Image size 1932x1932:
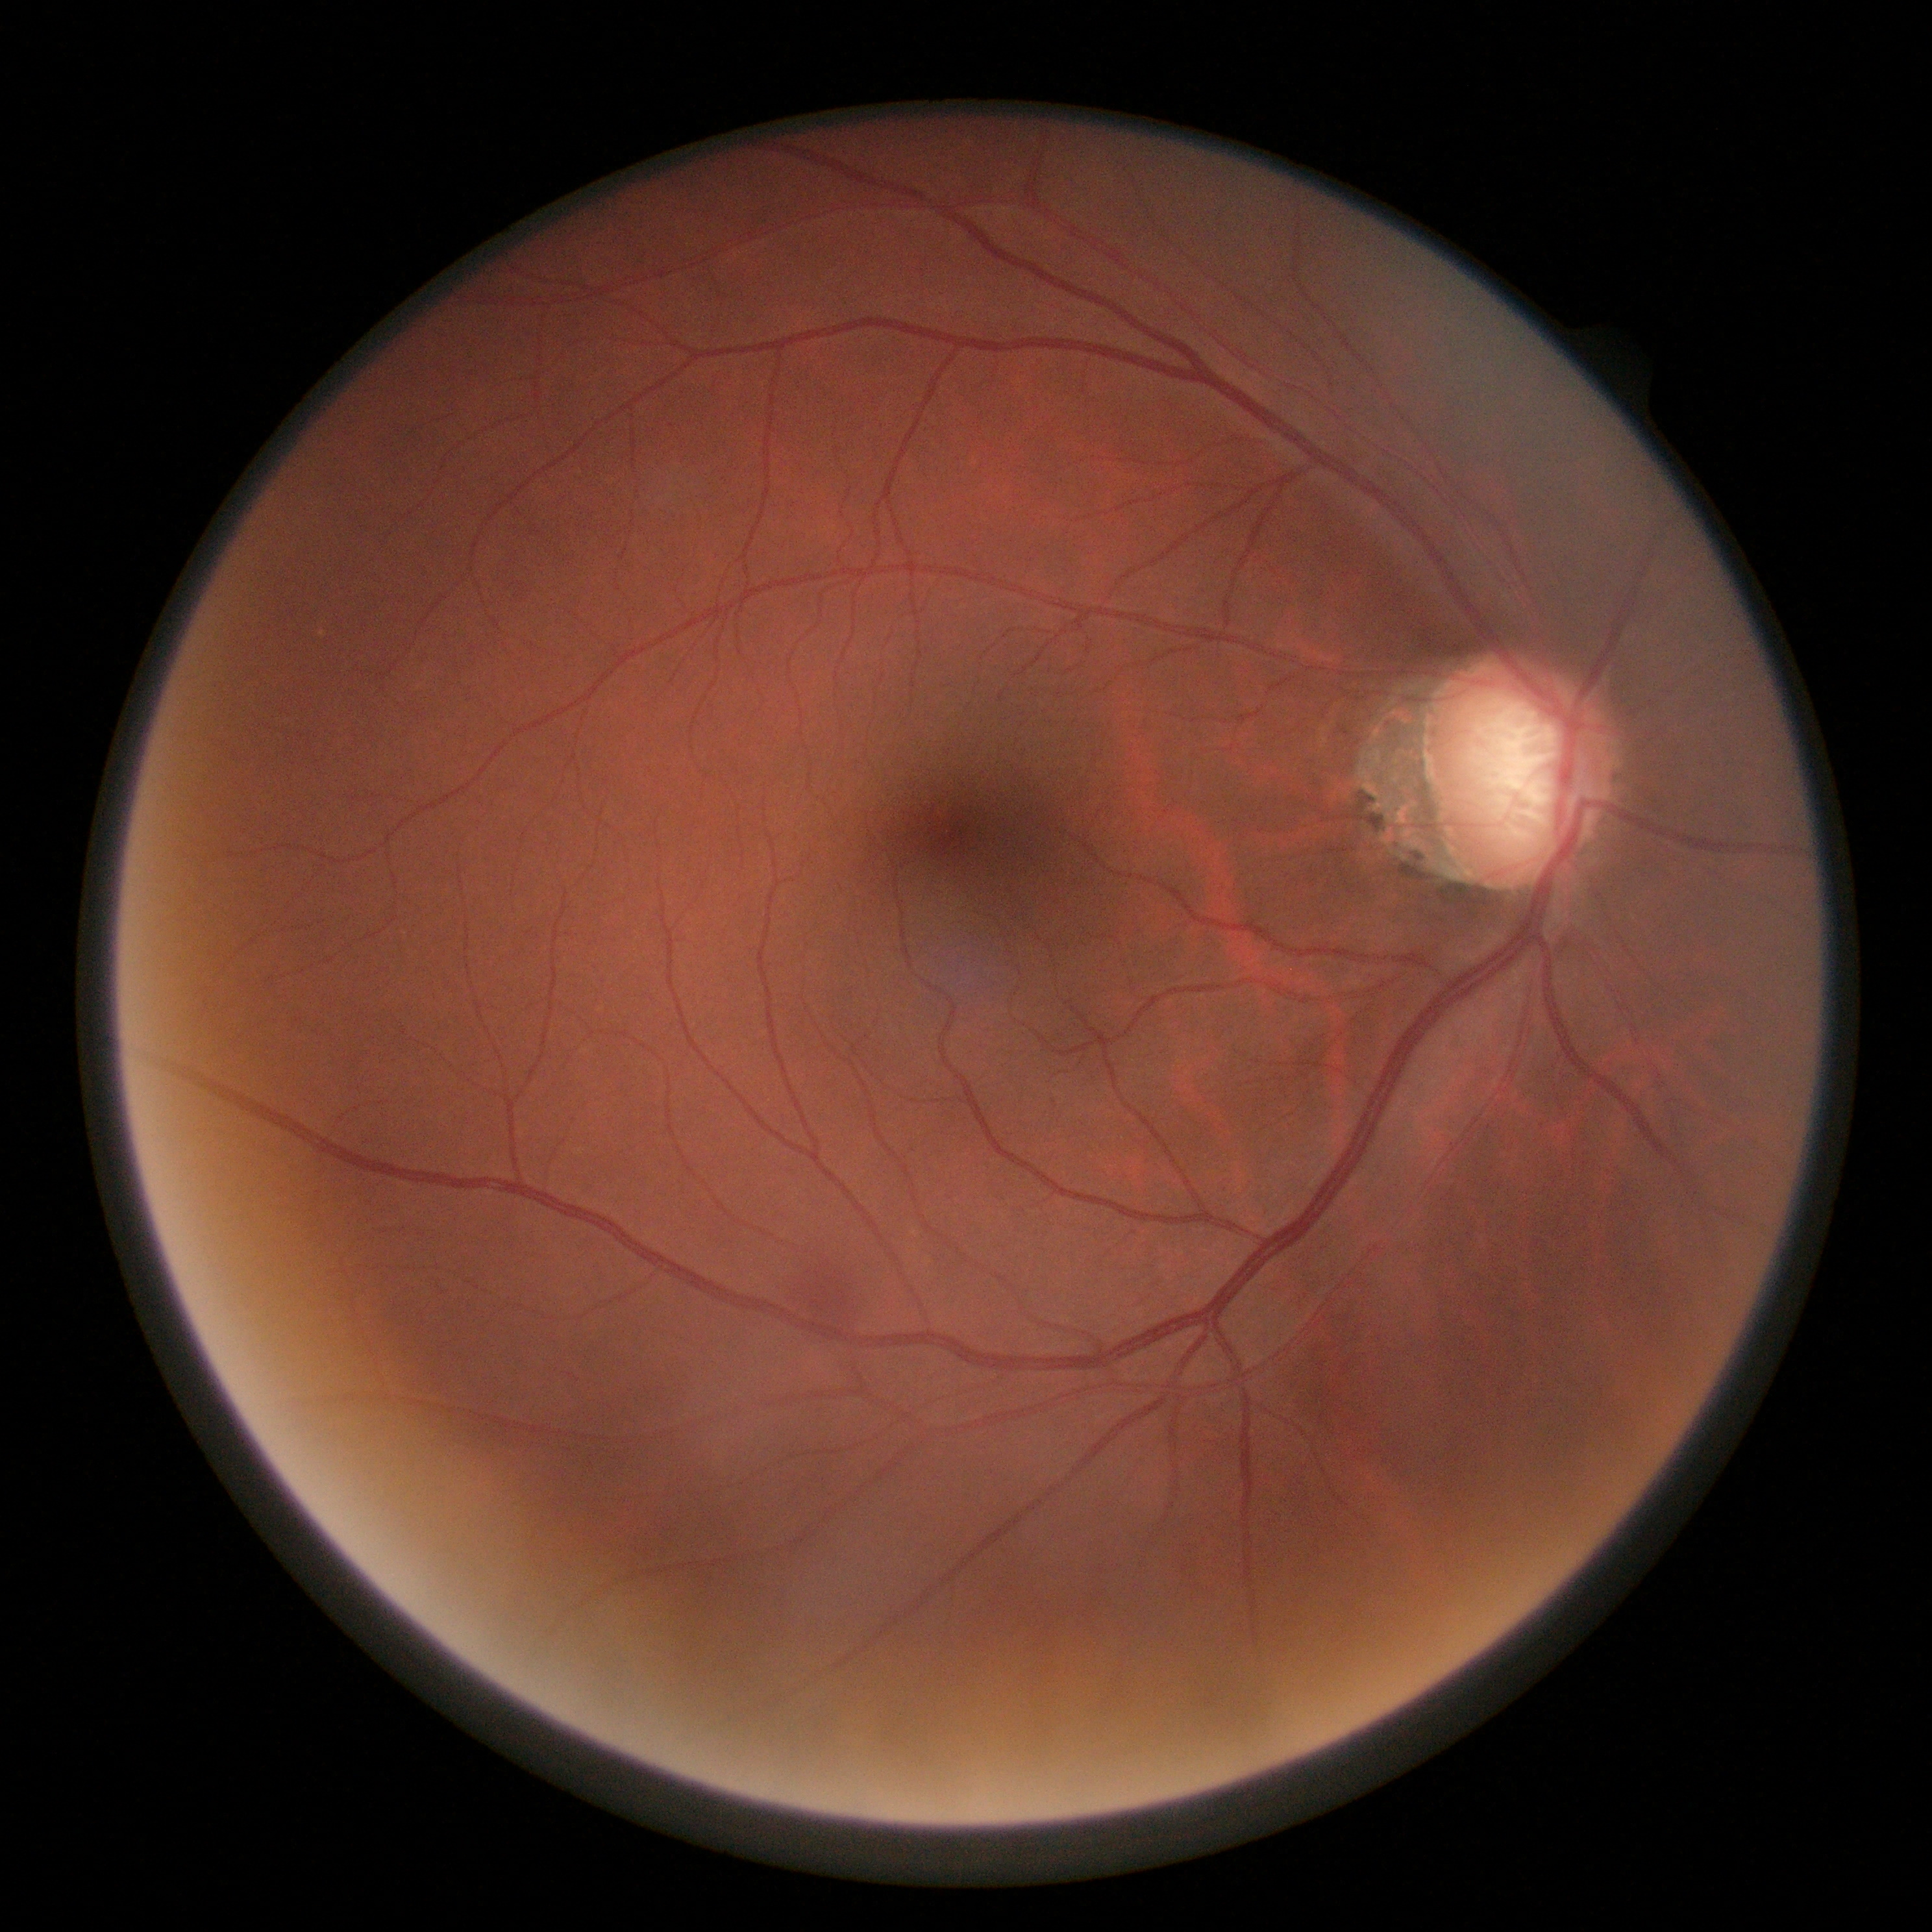
* diabetic retinopathy (DR): grade 2 (moderate NPDR)
* DR class: non-proliferative diabetic retinopathy